Without pupil dilation — 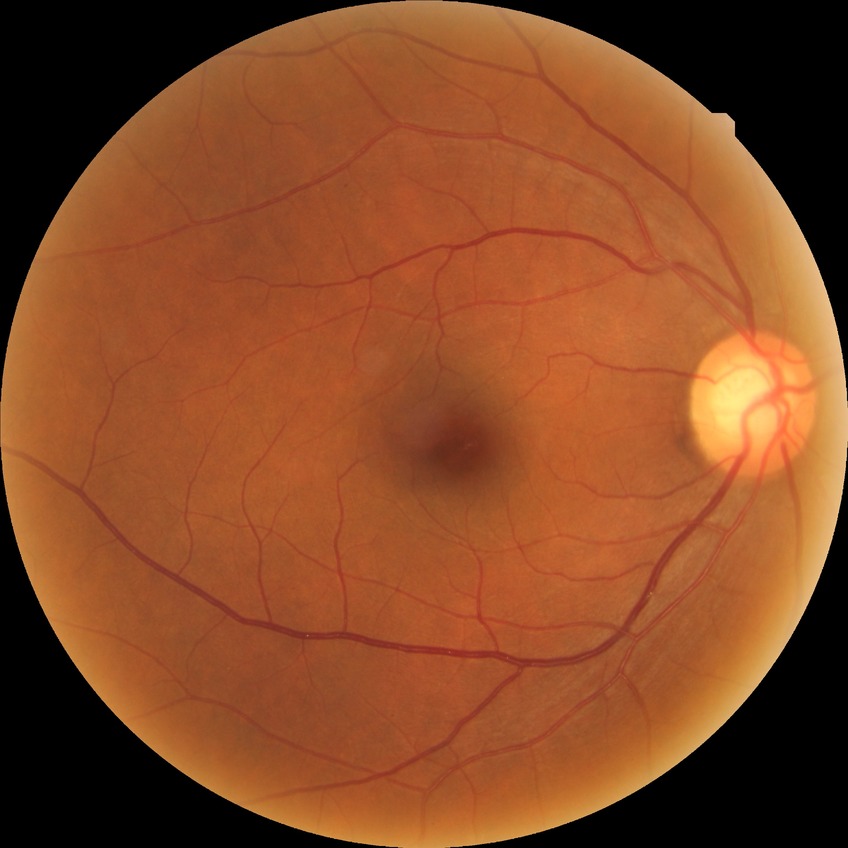 Modified Davis grading: simple diabetic retinopathy.